Diabetic retinopathy graded by the modified Davis classification: 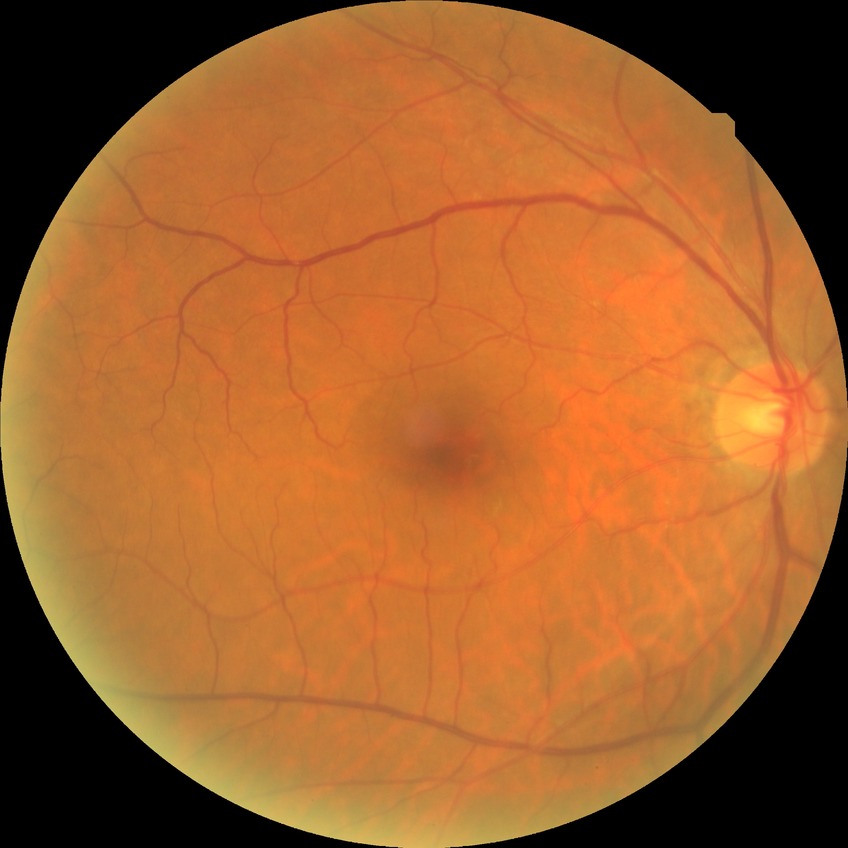 diabetic retinopathy (DR) = NDR (no diabetic retinopathy).